45° field of view.
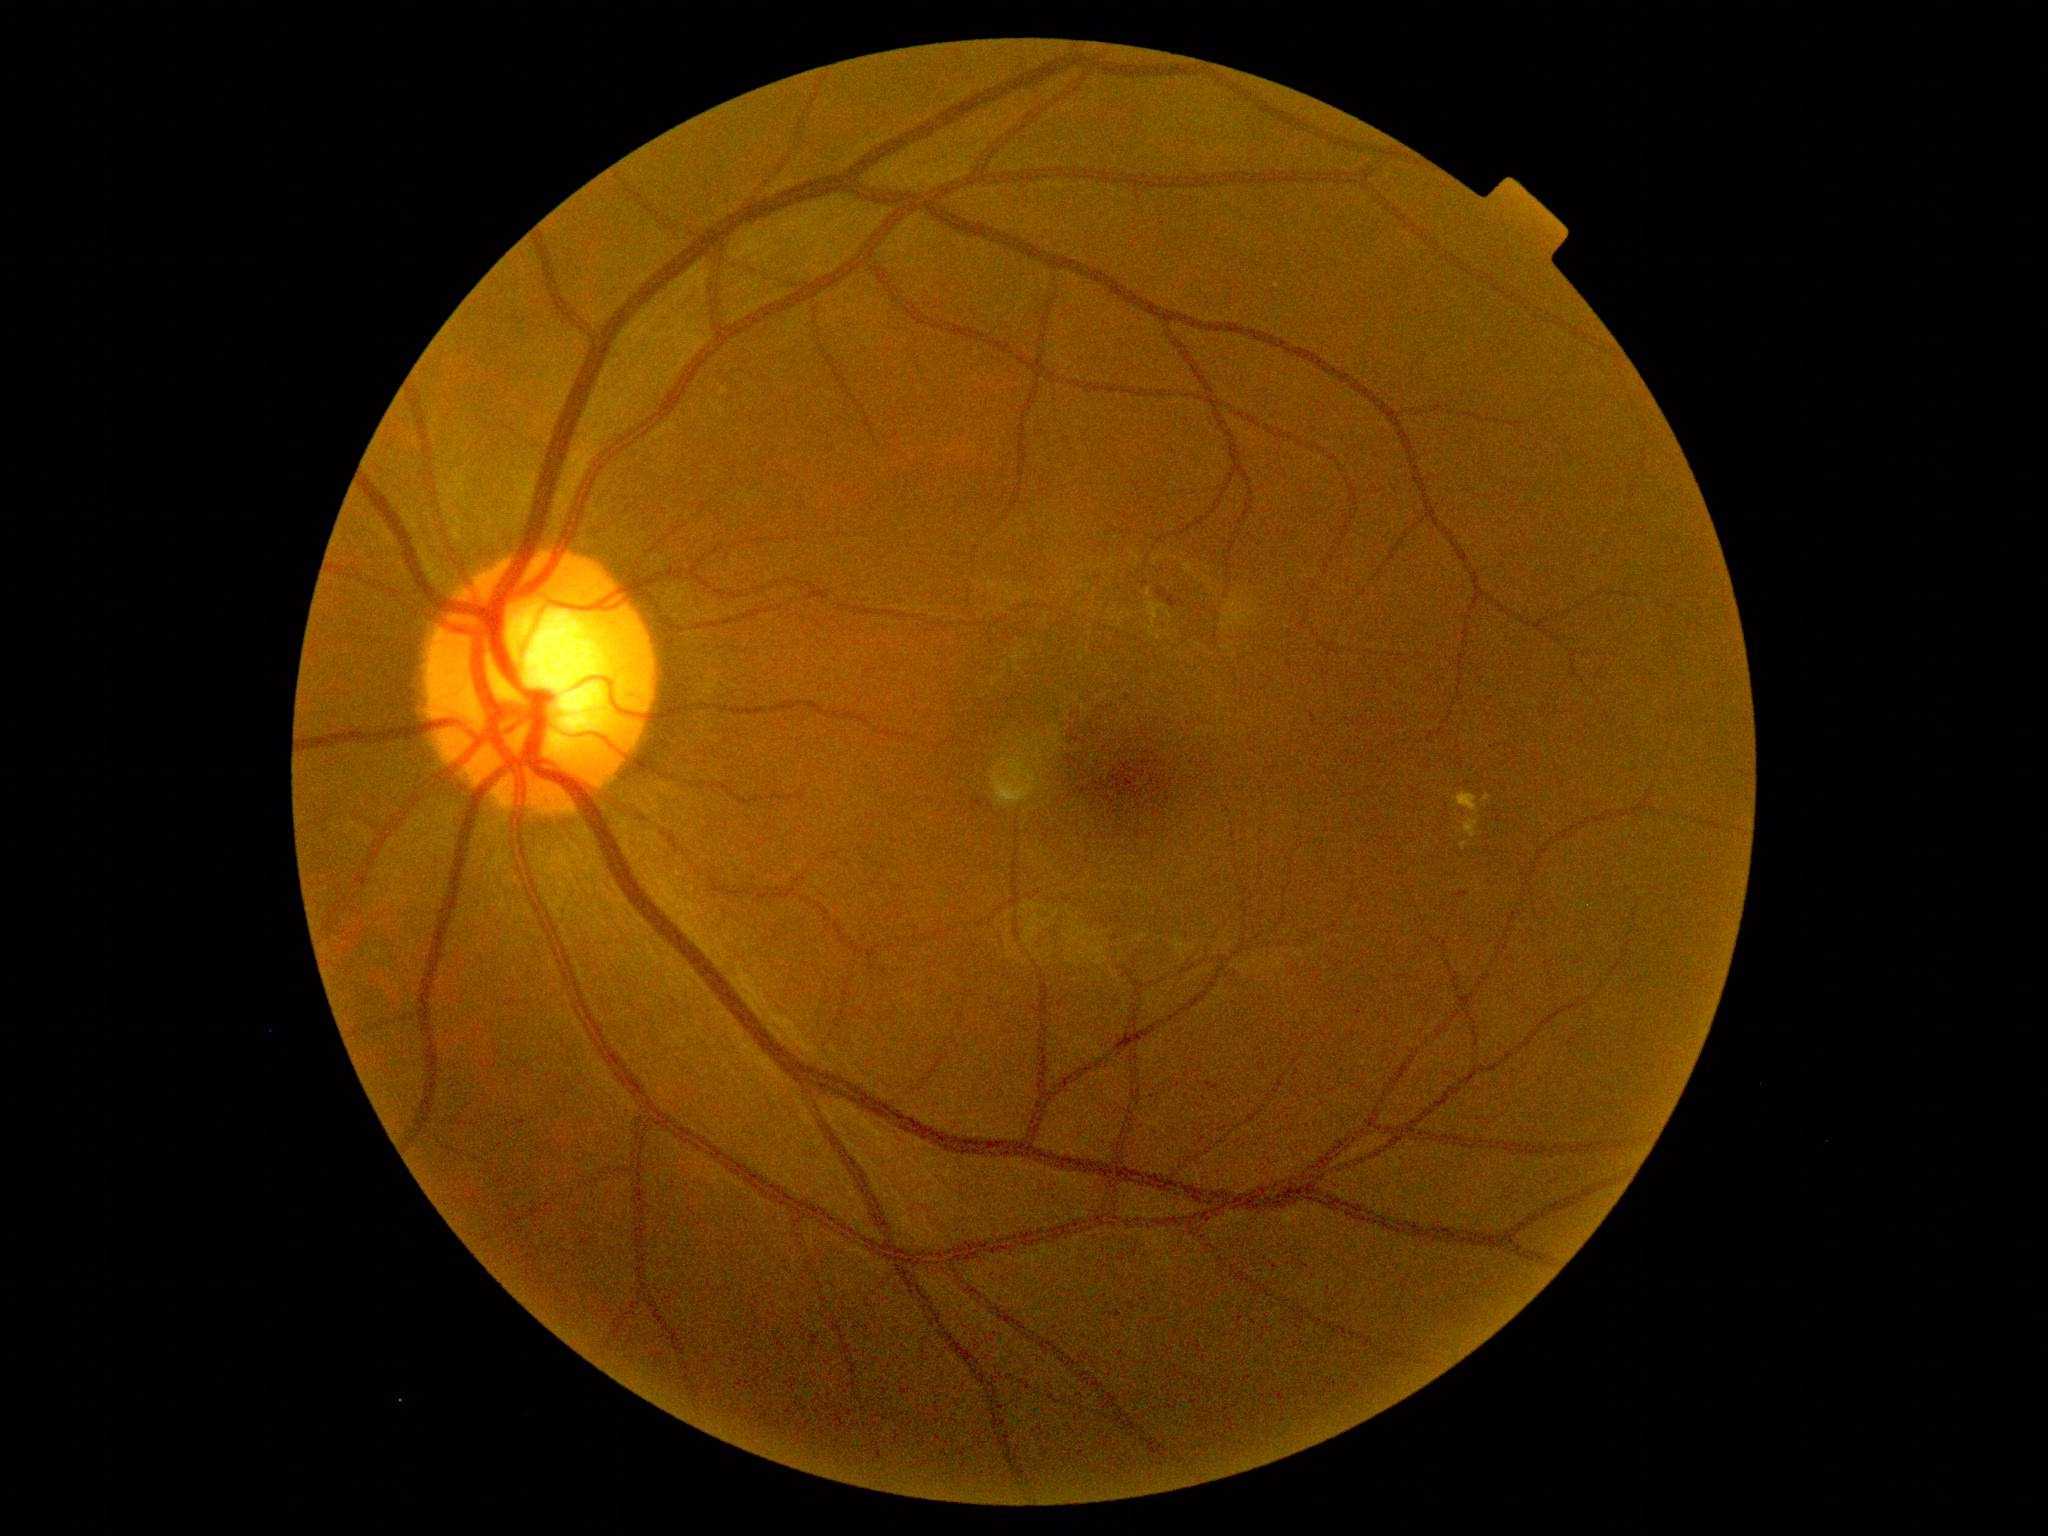 {"dr_grade": "2/4"}